Non-mydriatic fundus camera, disc-centered field, camera: Nidek AFC-330
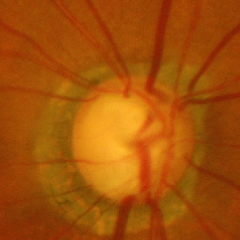

Advanced-stage glaucoma.